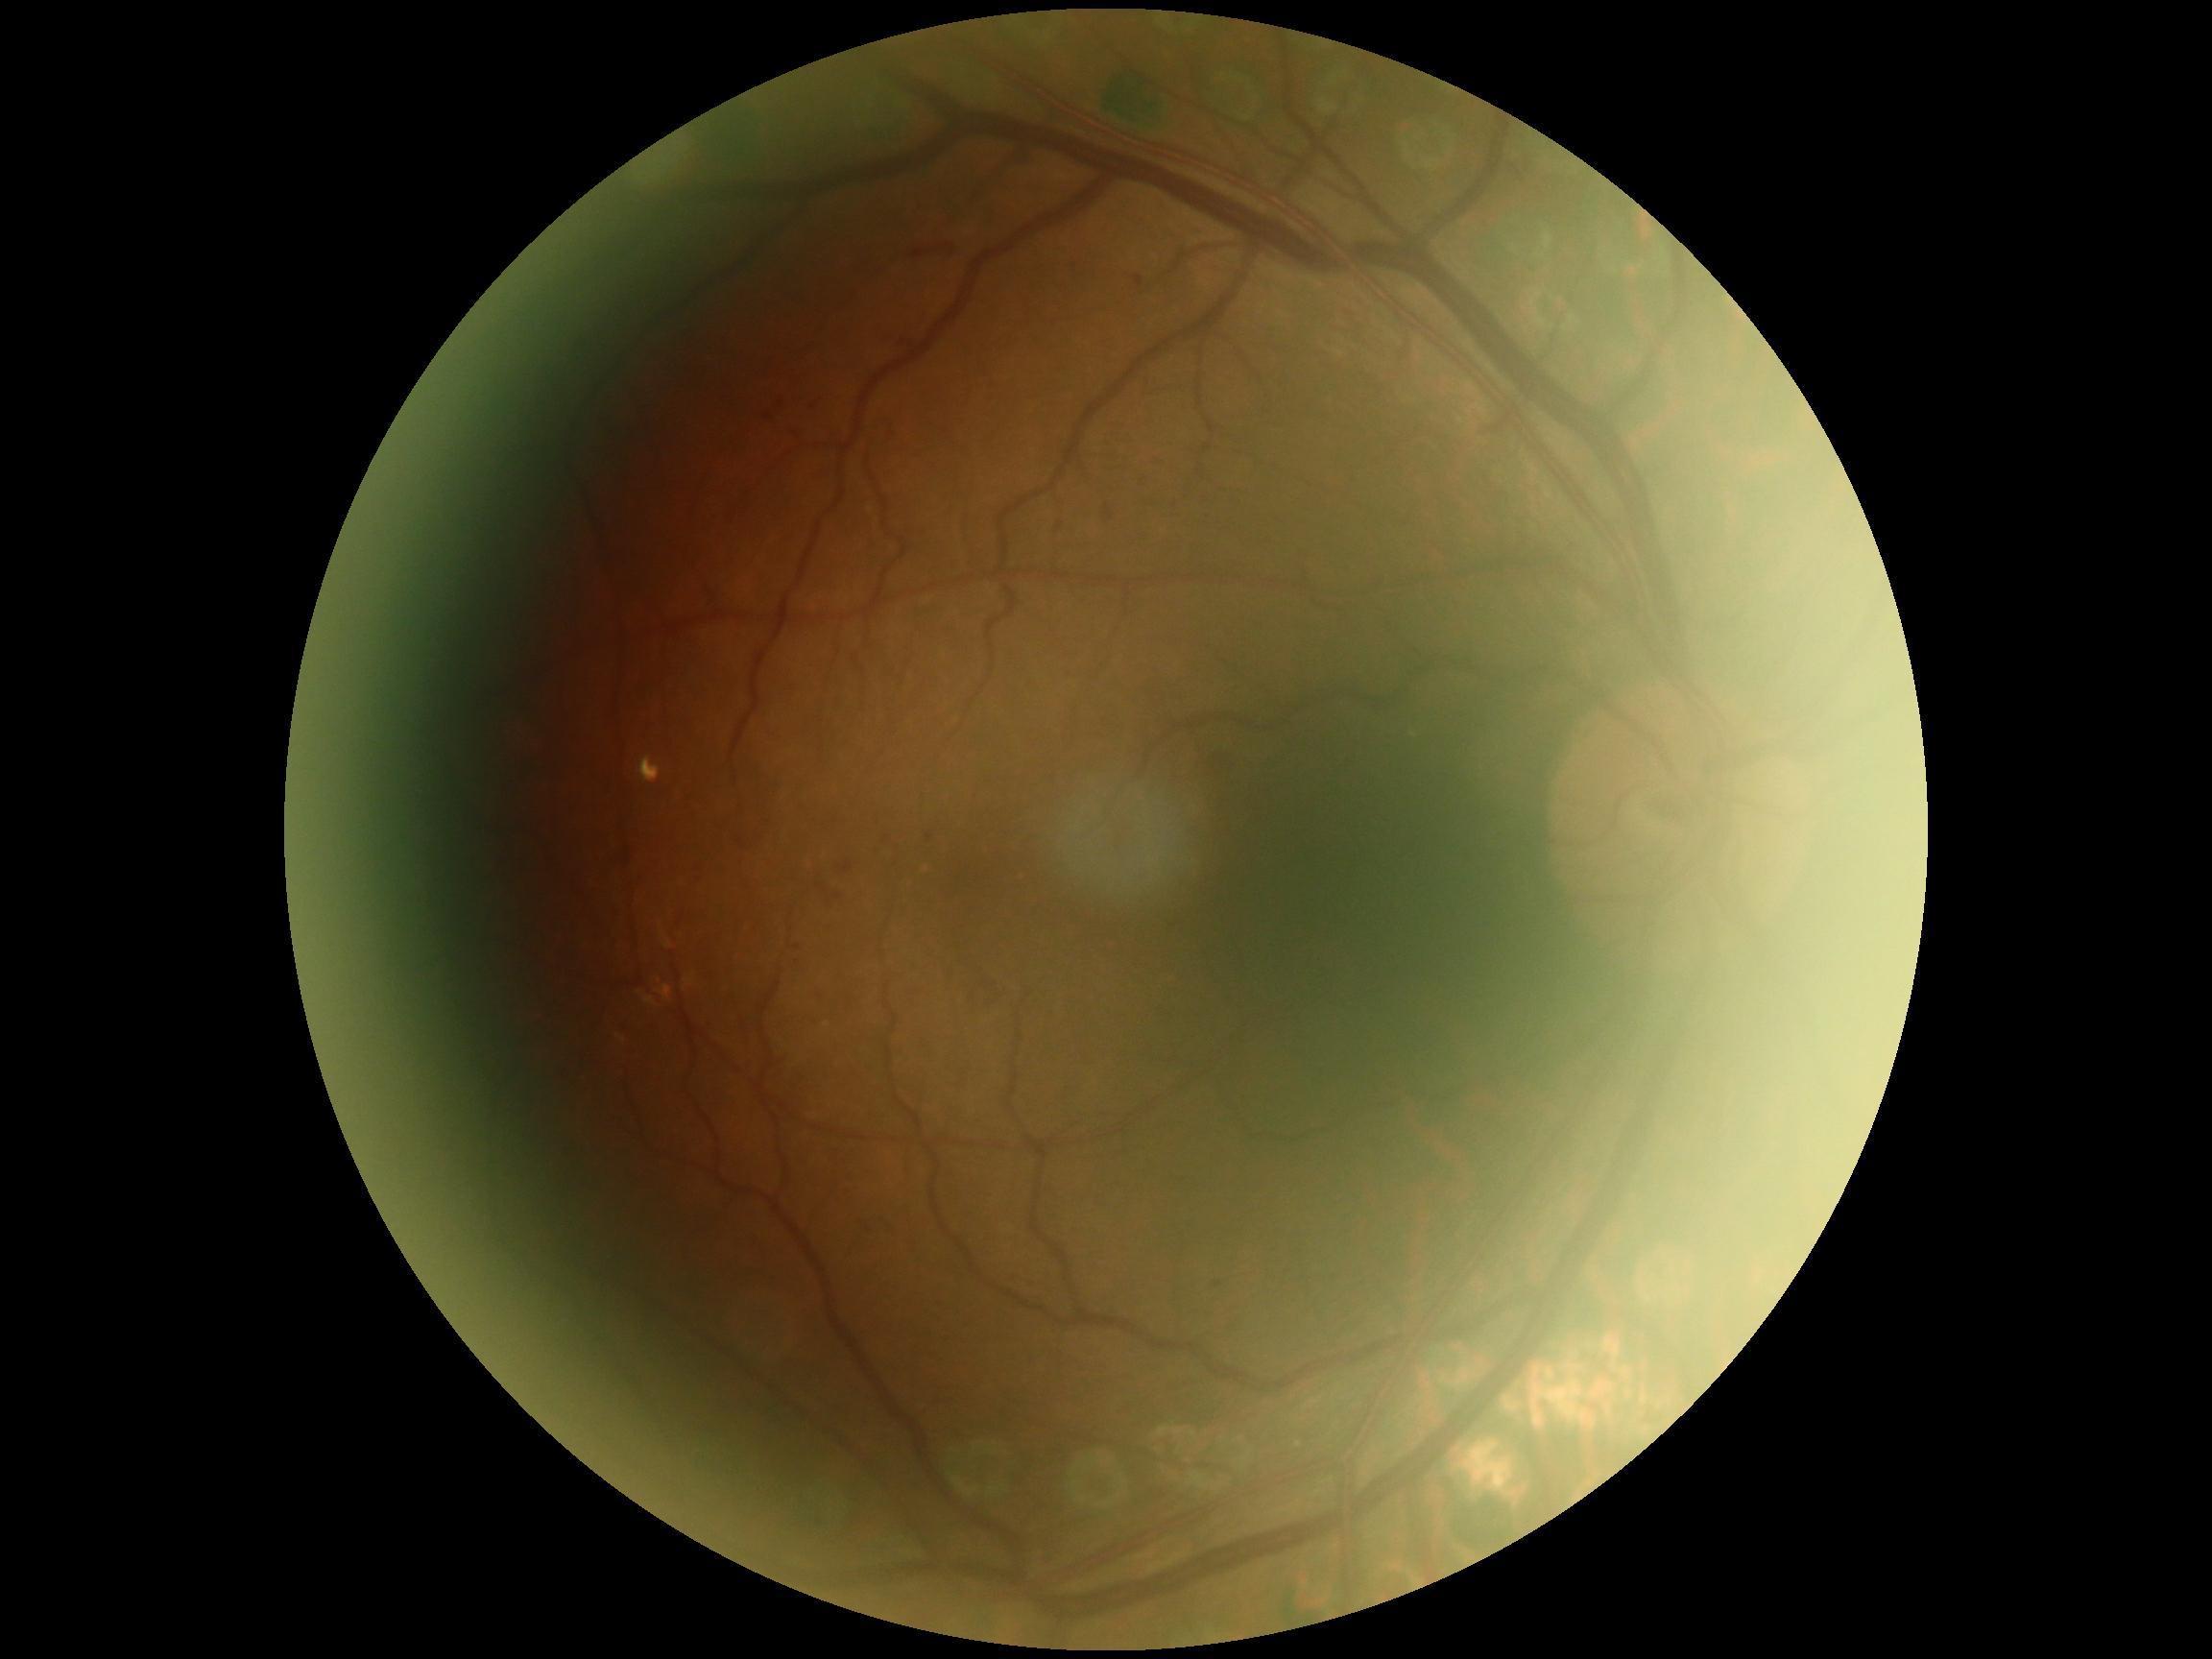 Diabetic retinopathy (DR): moderate NPDR (grade 2). The retinopathy is classified as non-proliferative diabetic retinopathy.